45-degree field of view · fundus photo · 2352x1568
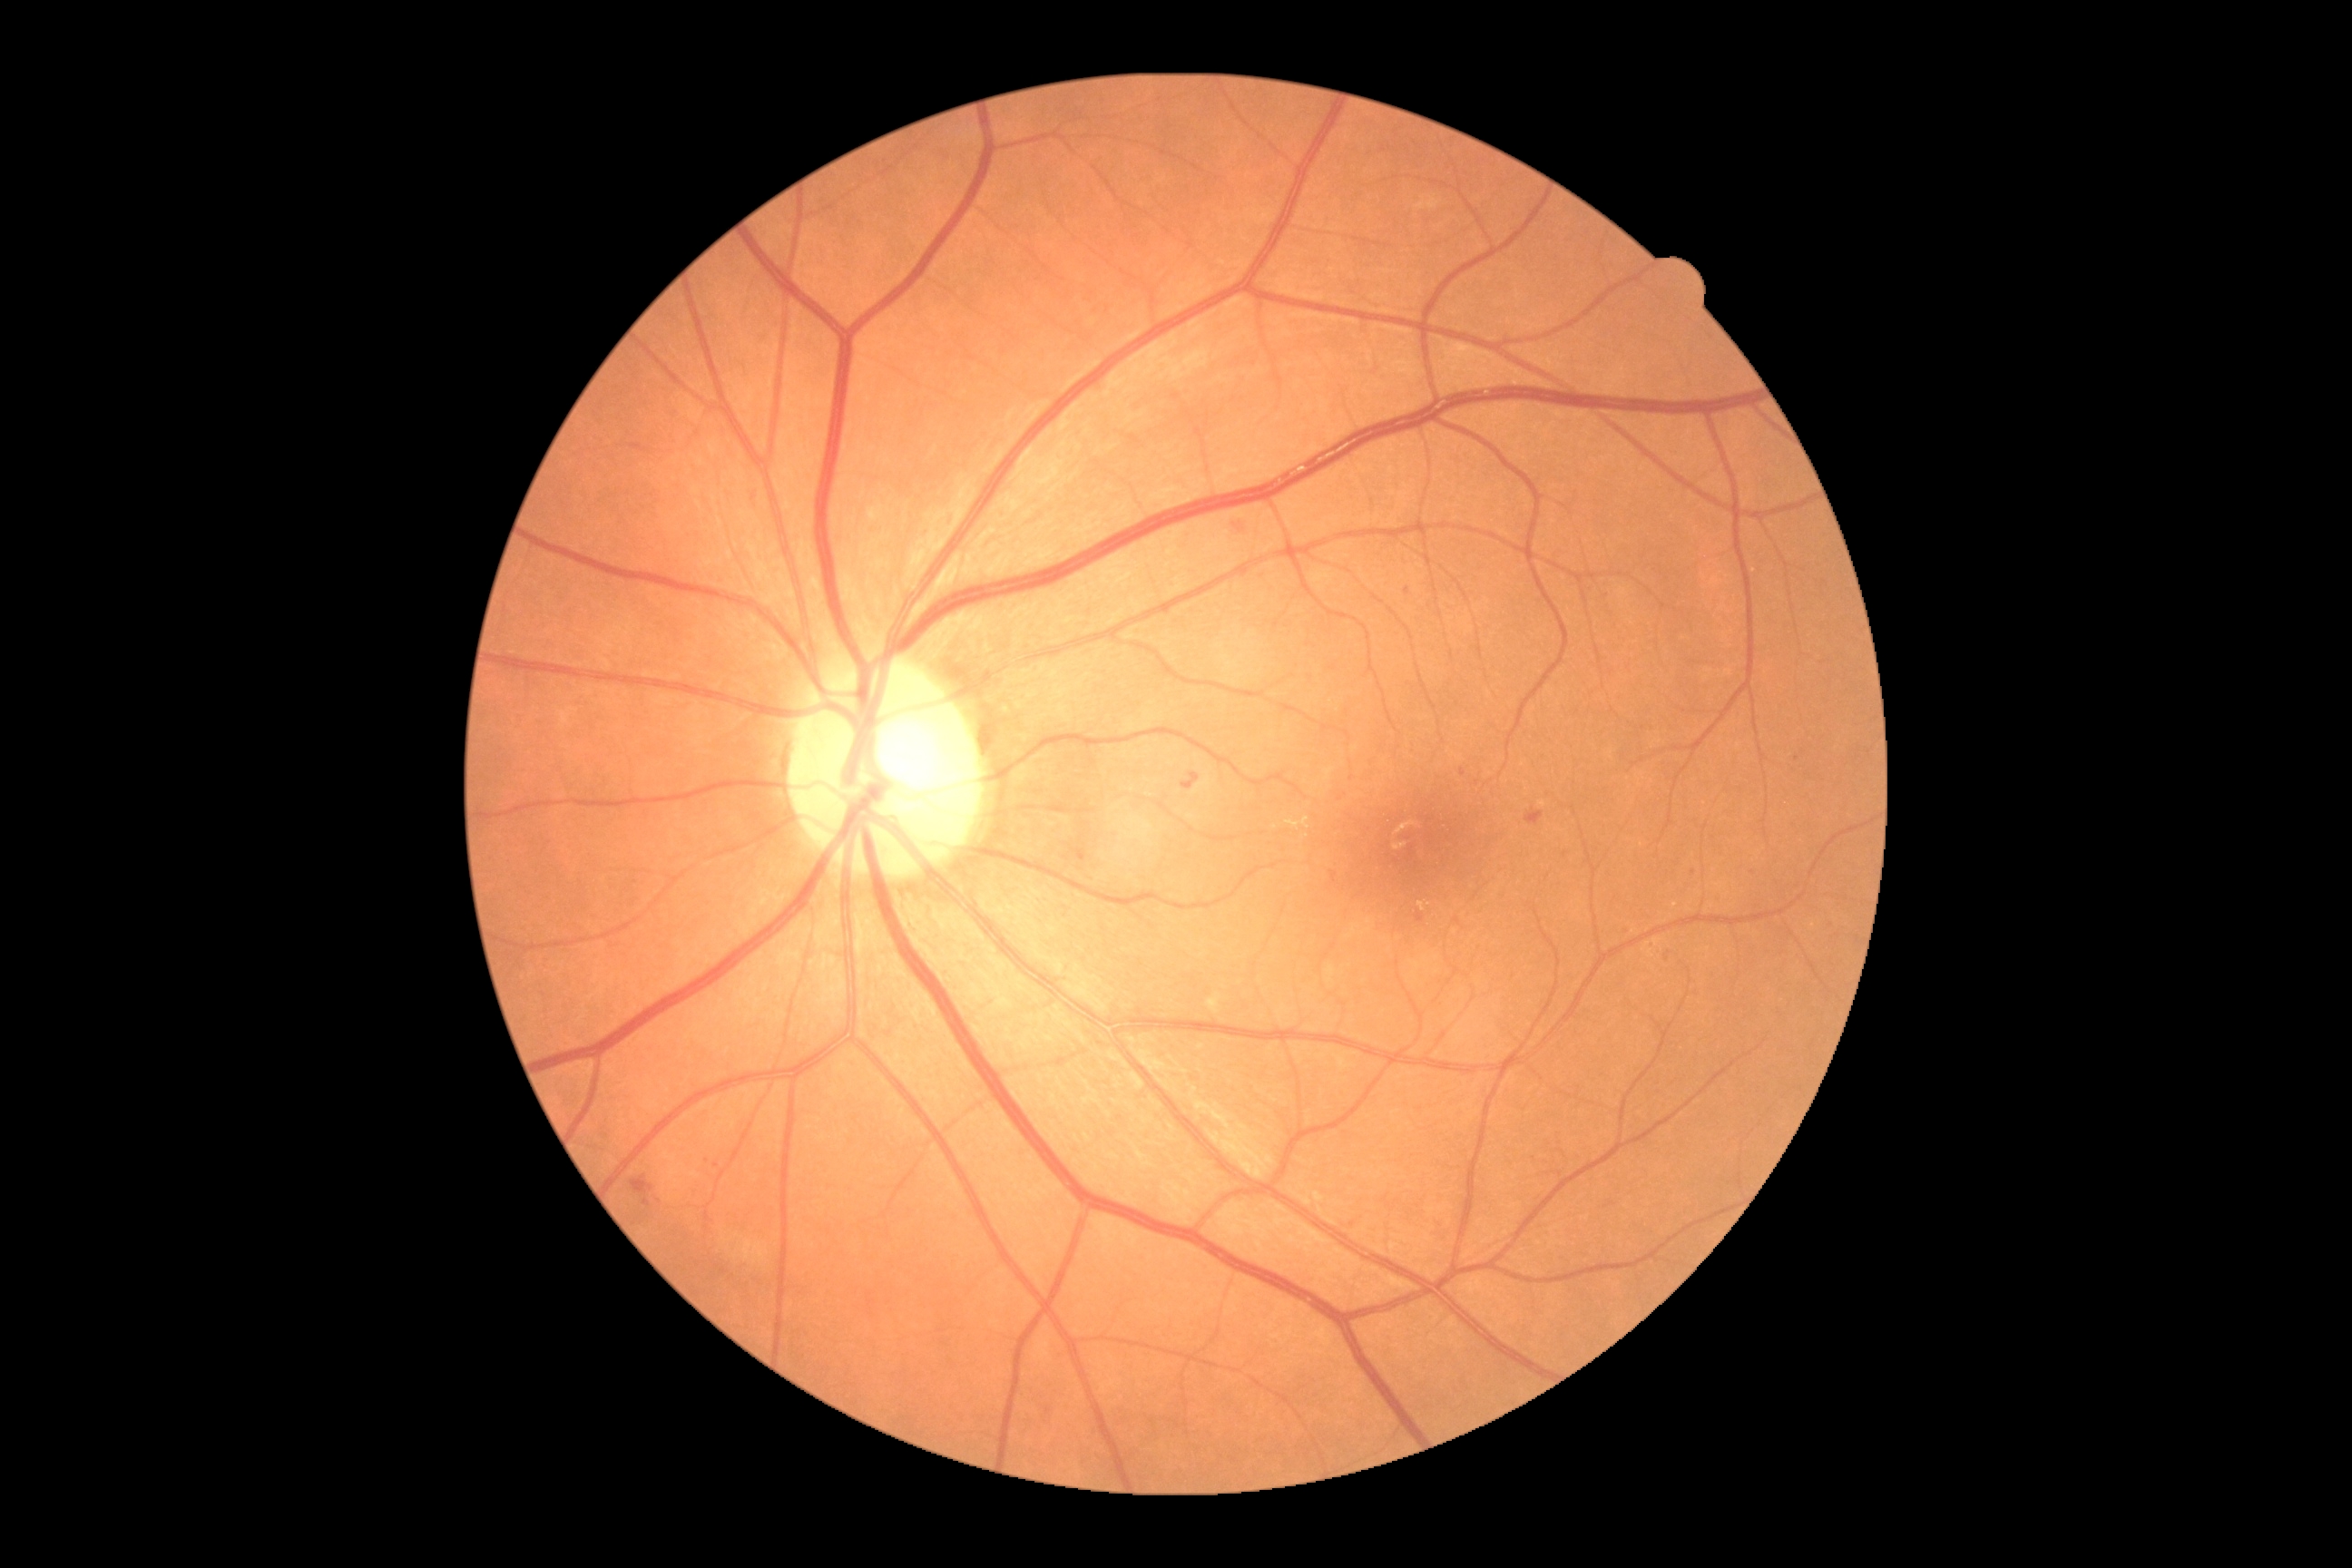 The retinopathy is classified as non-proliferative diabetic retinopathy. Diabetic retinopathy severity: grade 2 (moderate NPDR).